Retinal fundus photograph · acquired with a NIDEK AFC-230: 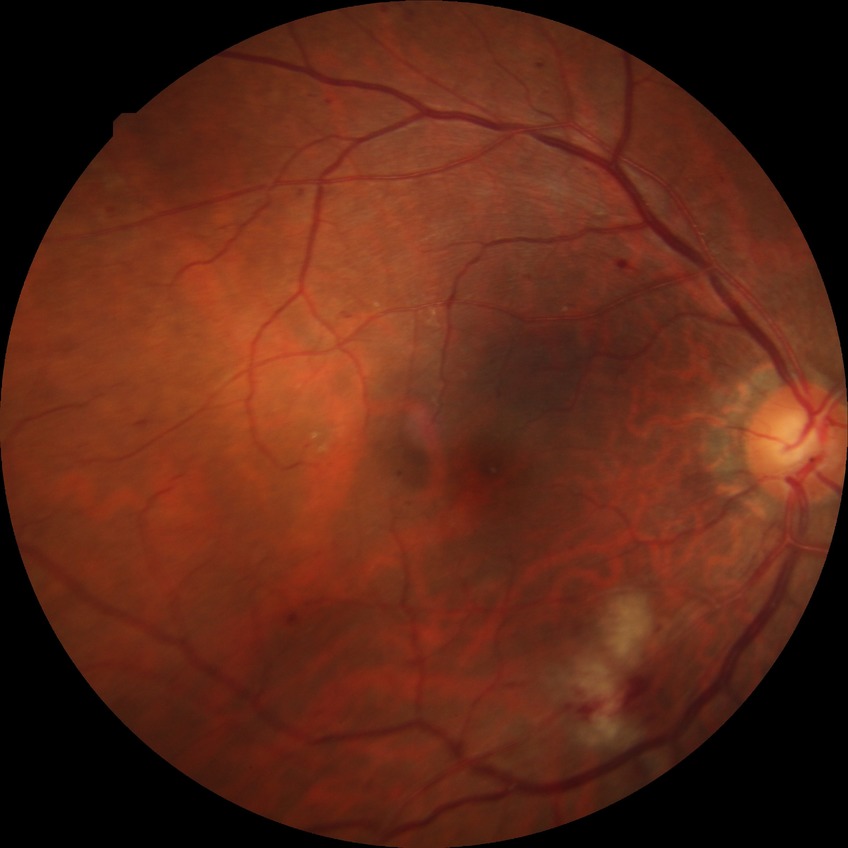

Modified Davis grade is PPDR. DR class: non-proliferative diabetic retinopathy.